Retinal fundus photograph.
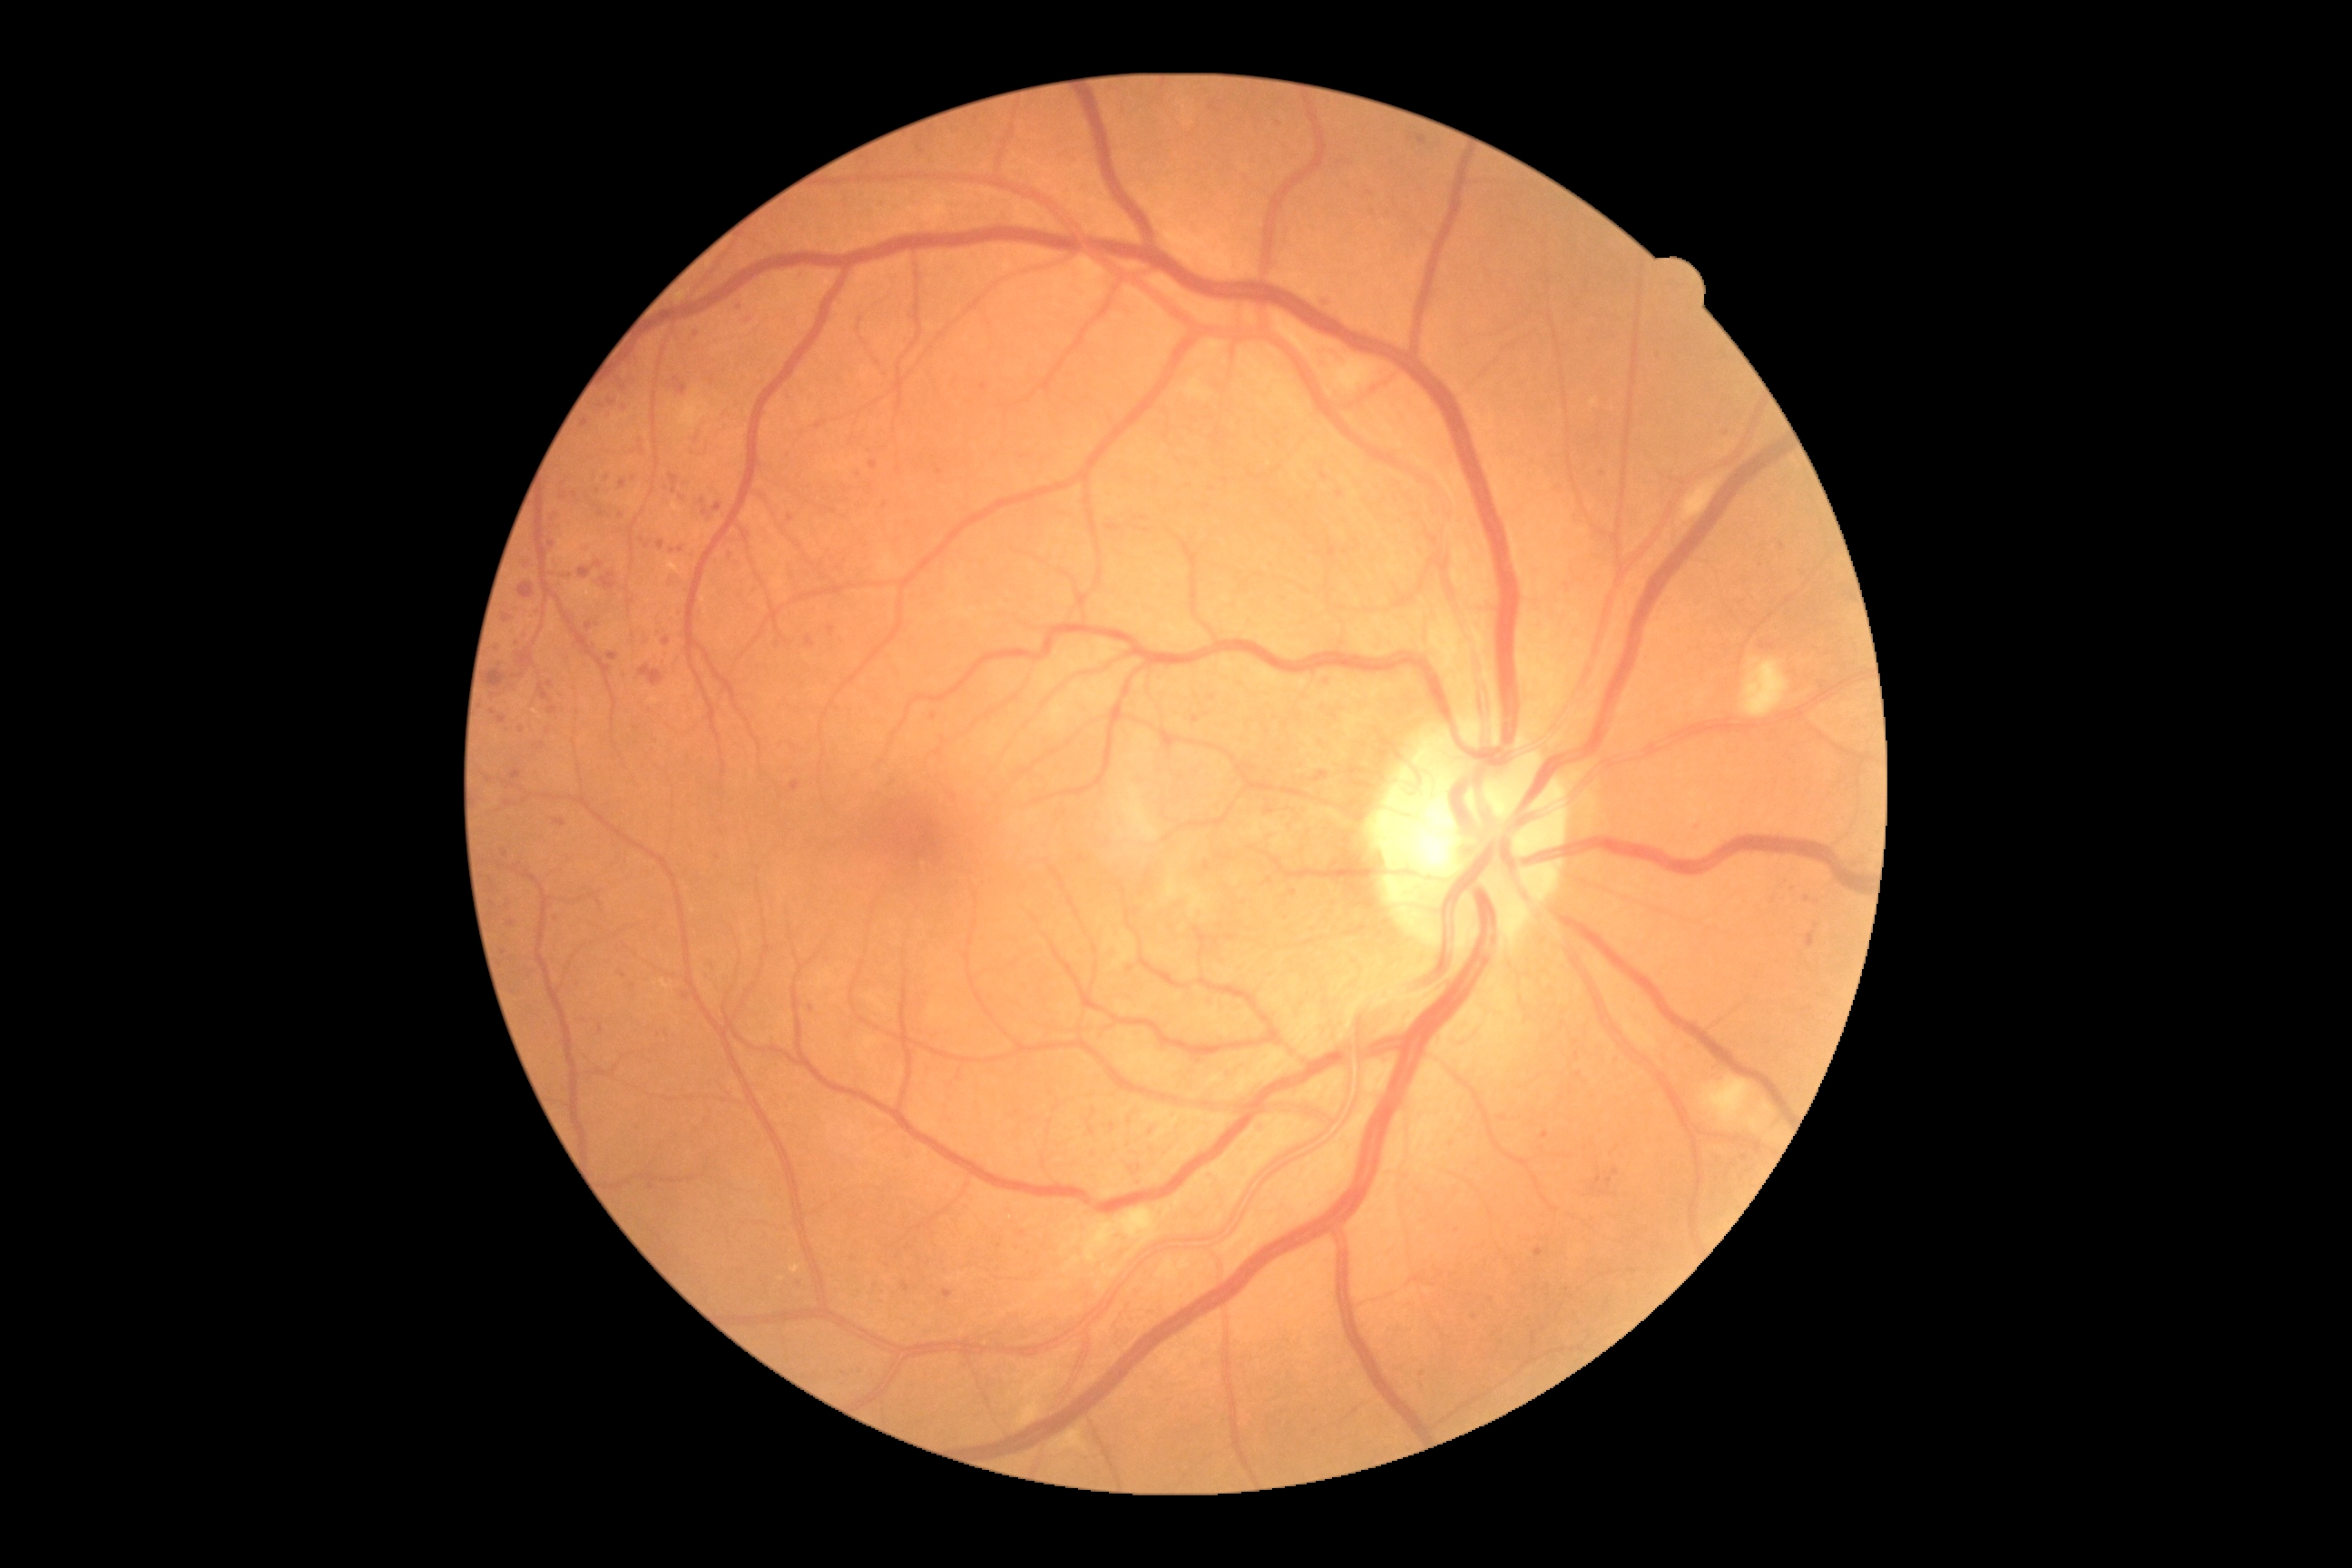 Diabetic retinopathy (DR): grade 2 — more than just microaneurysms but less than severe NPDR
Lesions identified (partial list):
microaneurysms (MAs) (subset): region(1692, 825, 1700, 830); region(504, 801, 513, 807); region(808, 1006, 814, 1014); region(1607, 1177, 1612, 1186); region(582, 418, 589, 429); region(663, 638, 671, 645); region(712, 504, 723, 513); region(1594, 1177, 1602, 1186)
MAs (small, approximate centers) near 673, 376; 611, 416; 714, 382; 648, 546; 503, 953; 1260, 1130; 493, 904; 1051, 1122; 1599, 473